2102x1736px:
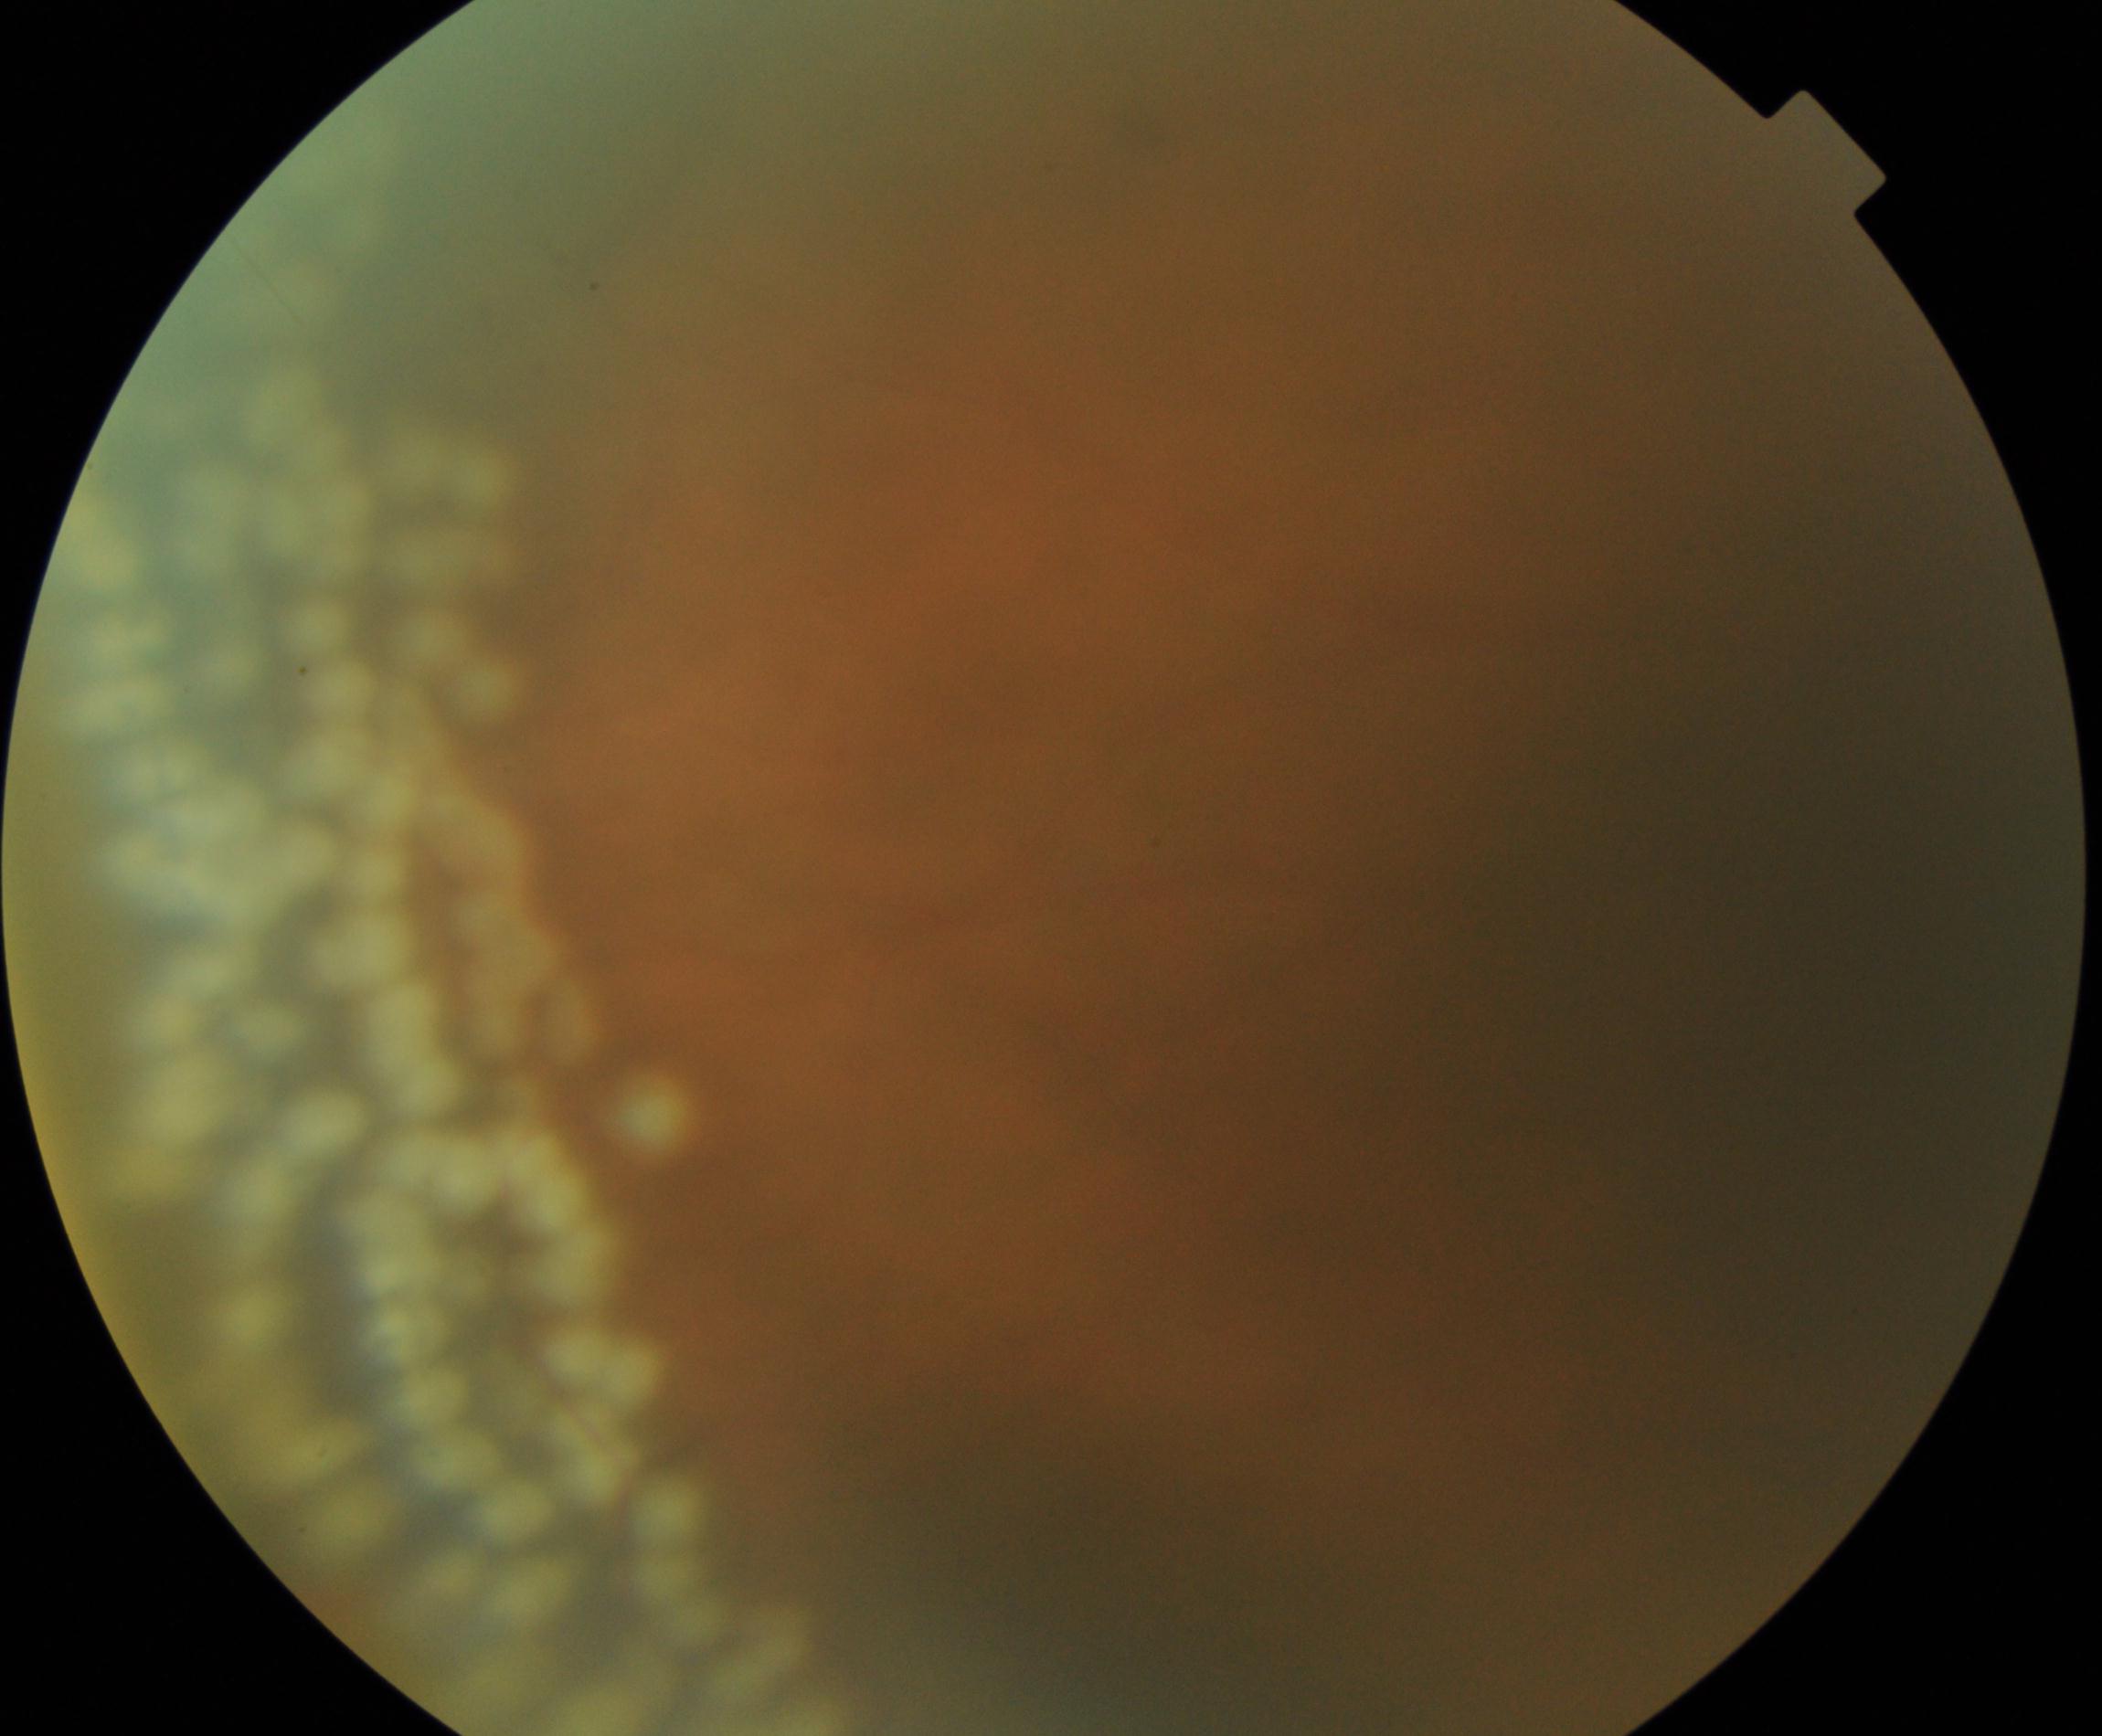

Laser spots, consistent with prior treatment.